100° field of view (Phoenix ICON) · wide-field fundus photograph from neonatal ROP screening · image size 1240x1240 — 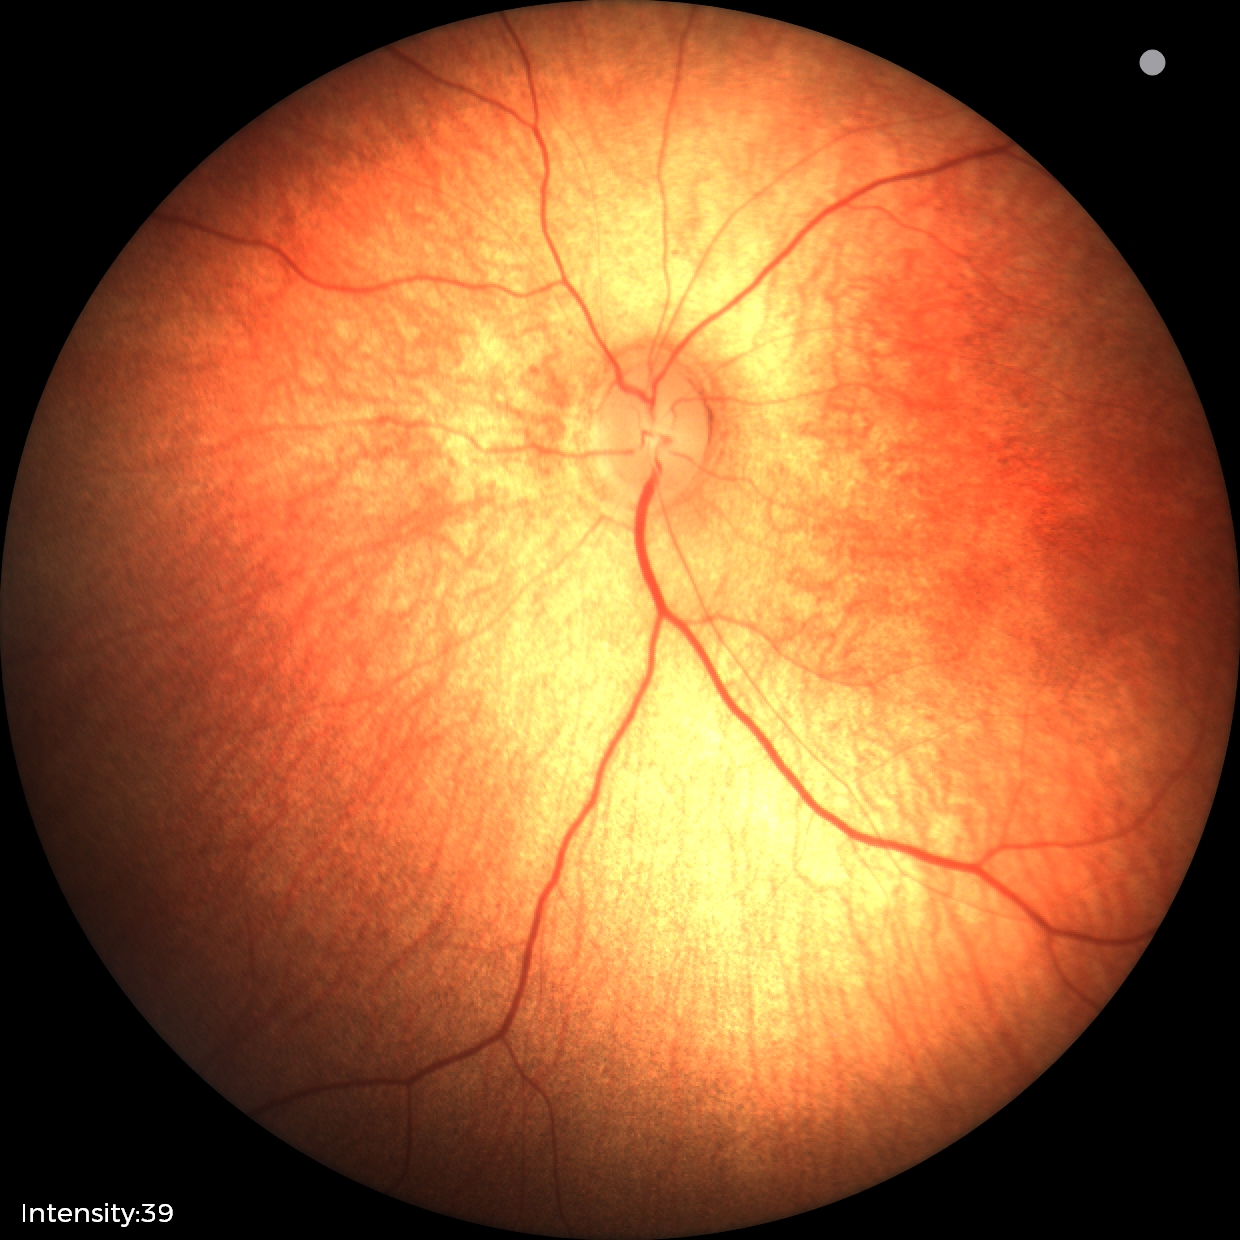
Screening examination with no abnormal retinal findings.